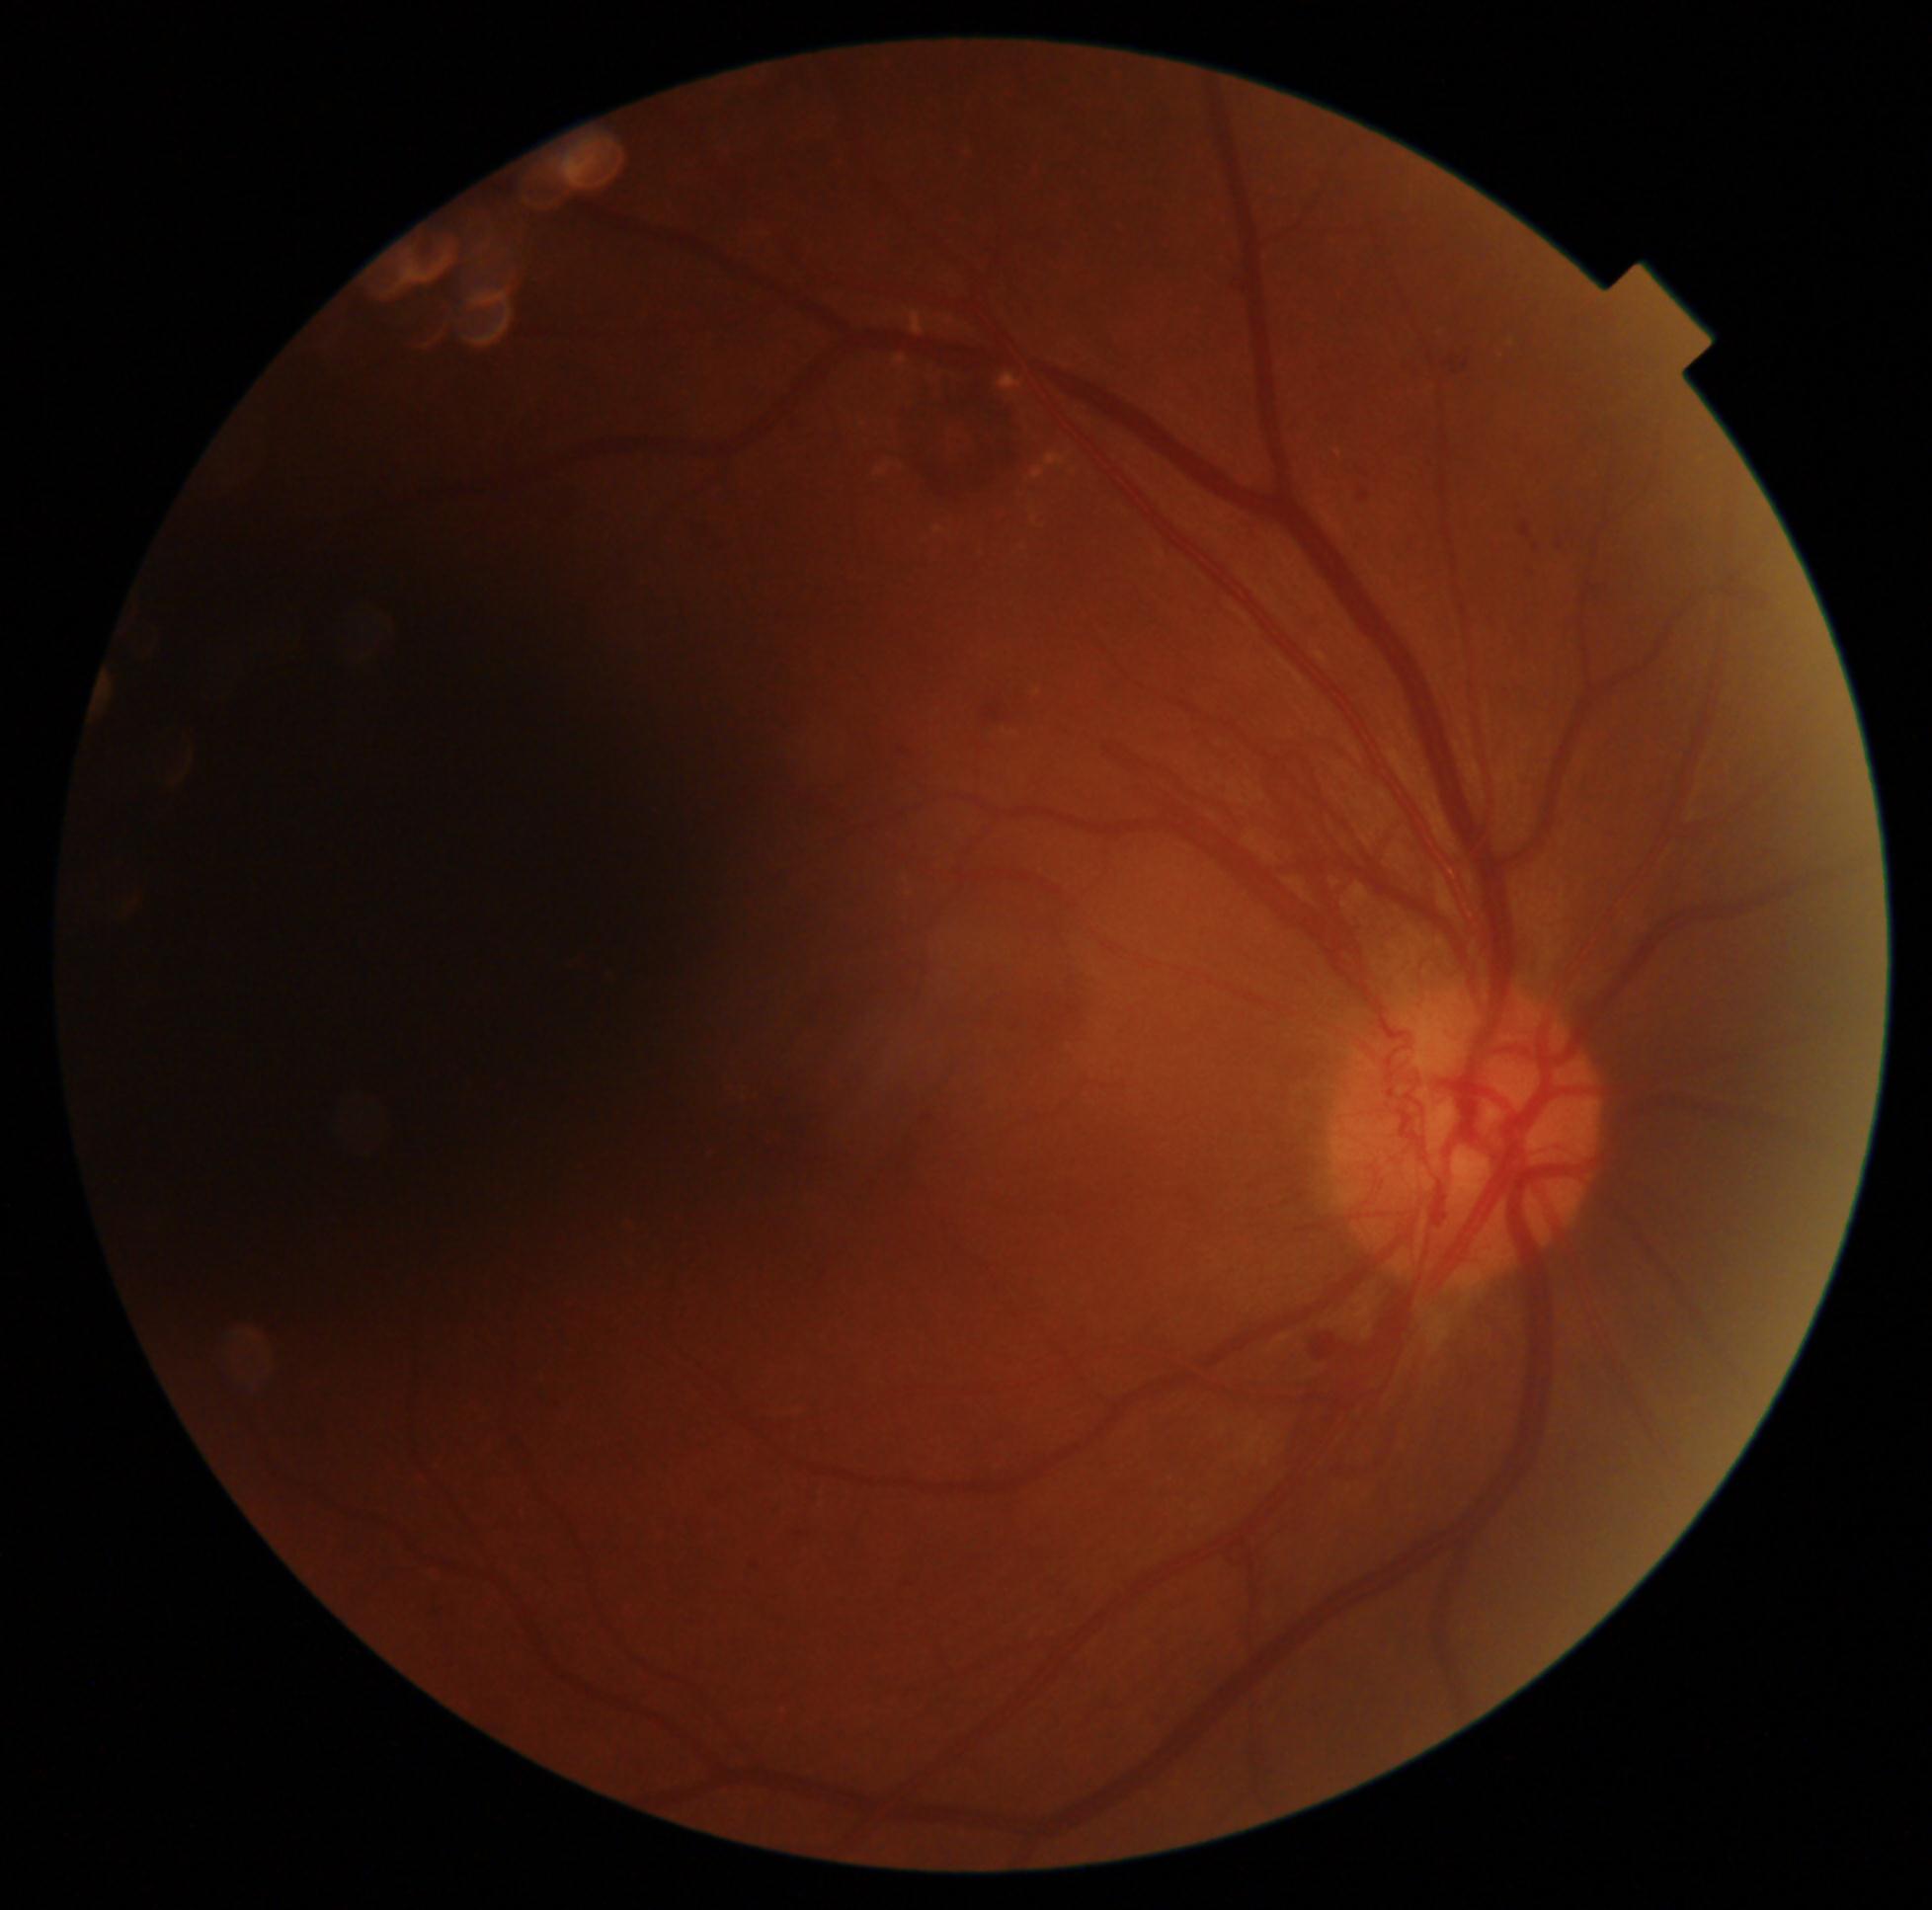
diabetic retinopathy (DR)=grade 4 (PDR).